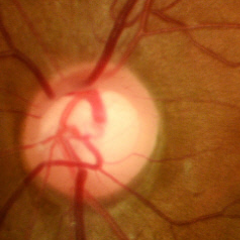
Glaucoma assessment: no glaucomatous findings.